DR severity per modified Davis staging
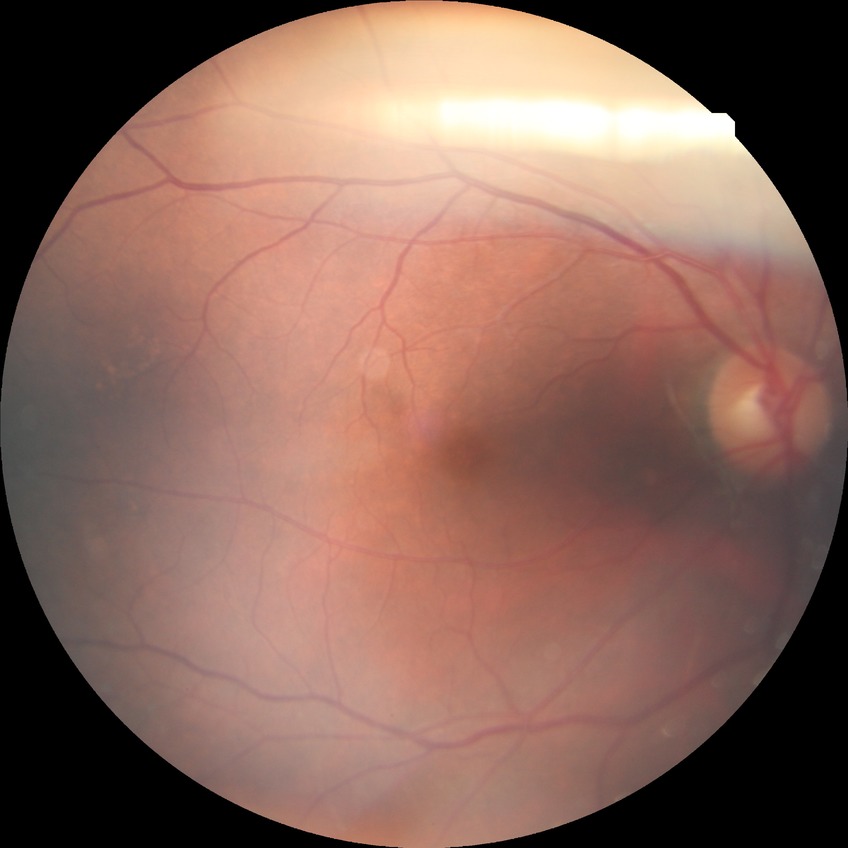 {
  "davis_grade": "no diabetic retinopathy"
}